Modified Davis classification — 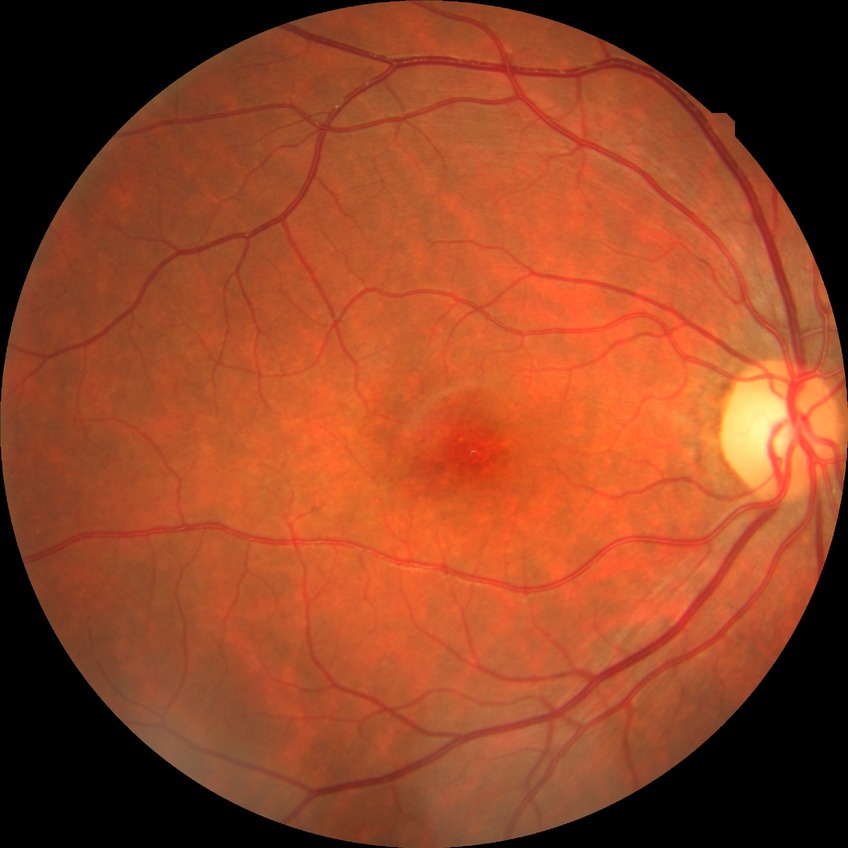
Diabetic retinopathy (DR) is NDR (no diabetic retinopathy).